Pediatric retinal photograph (wide-field):
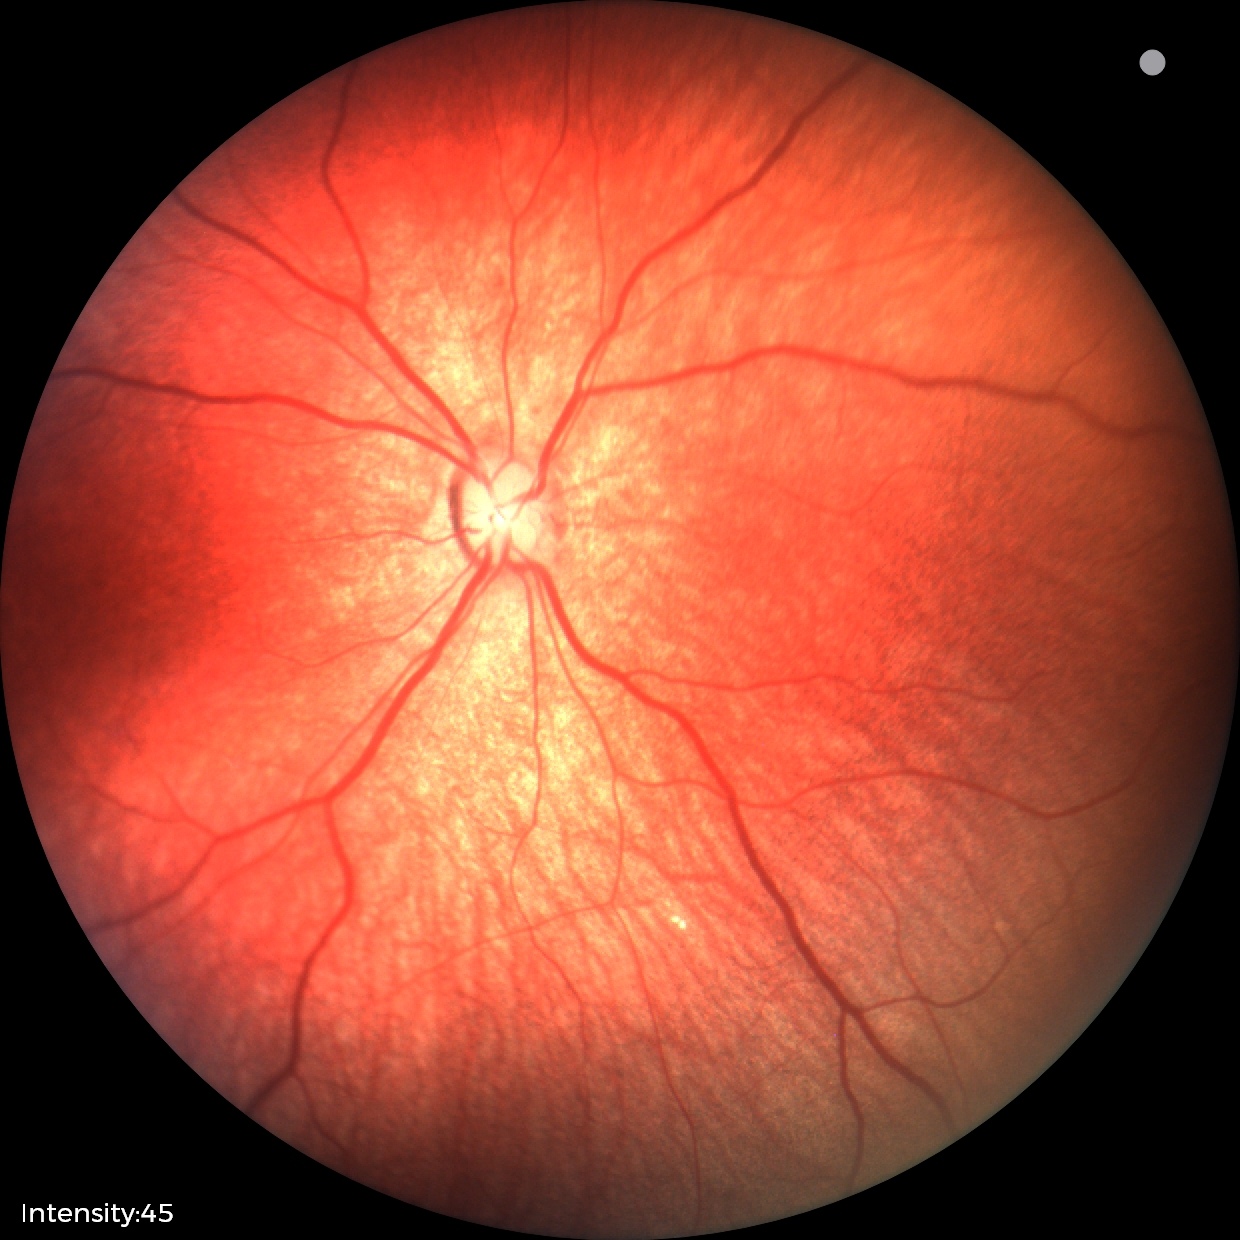 Q: What is the screening diagnosis?
A: physiological retinal finding